Fundus photo · 2048x1536 · FOV: 45 degrees:
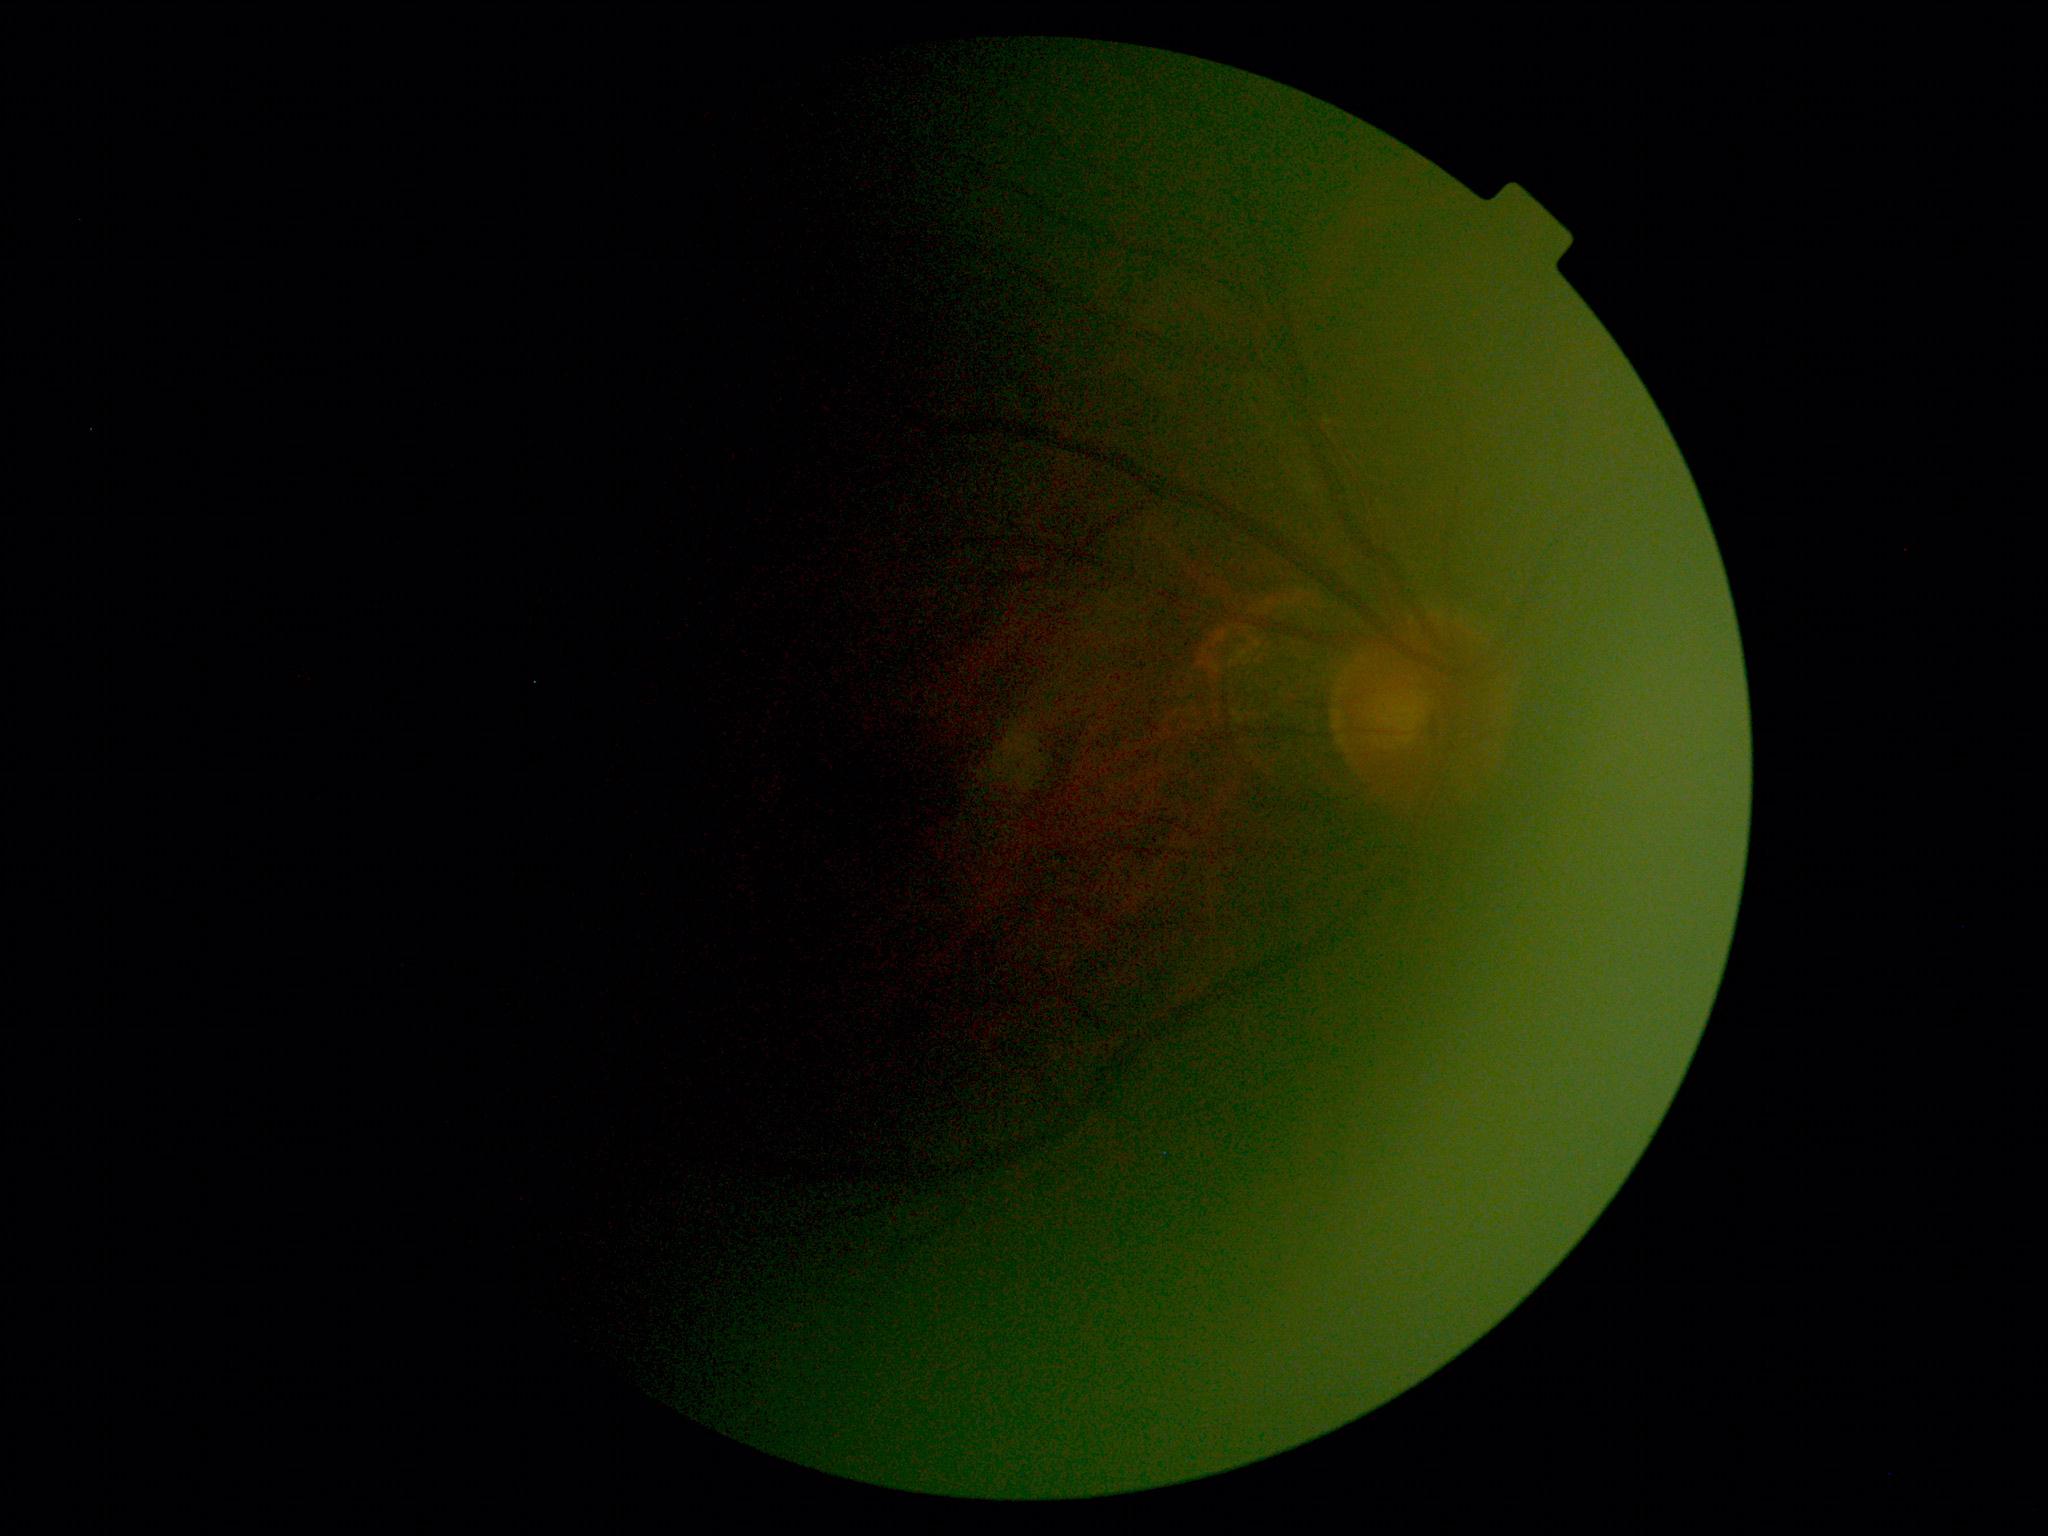 Diabetic retinopathy is ungradable due to poor image quality.
Image quality is insufficient for diabetic retinopathy assessment.